Camera: NIDEK AFC-230; modified Davis classification — 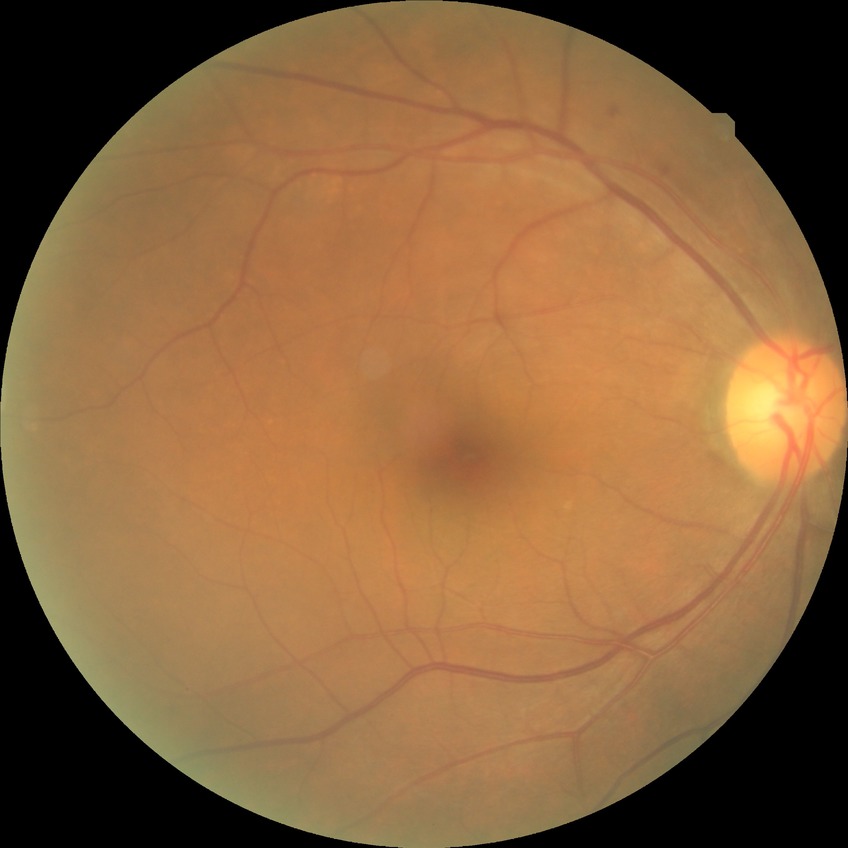 diabetic retinopathy (DR)=NDR (no diabetic retinopathy).